Graded on the modified Davis scale — 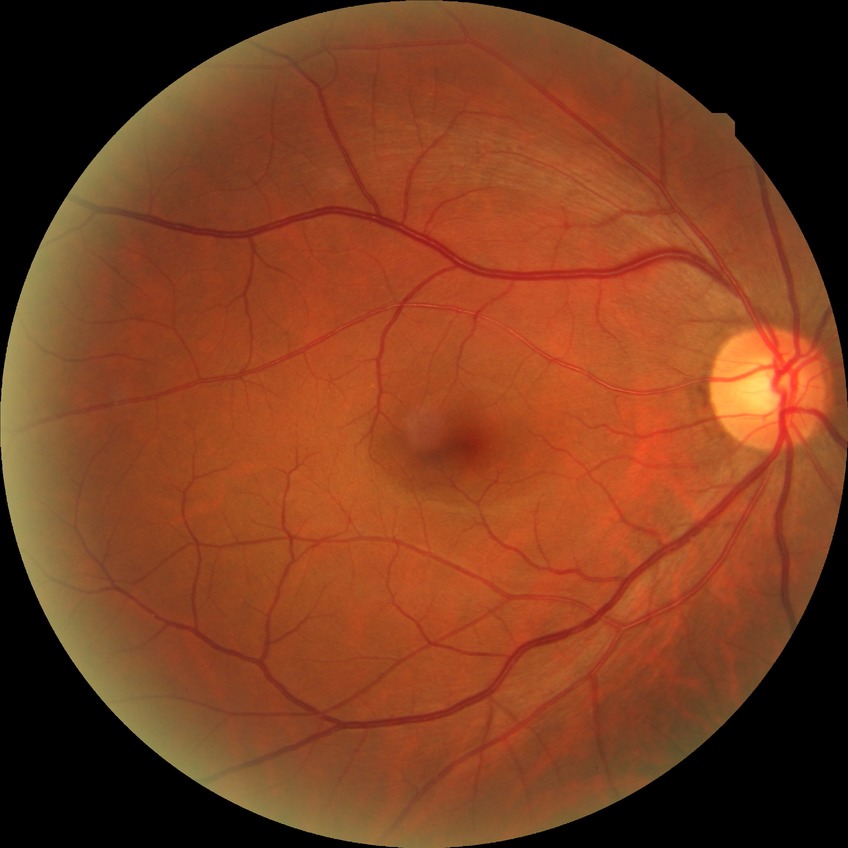

Diabetic retinopathy (DR) is no diabetic retinopathy (NDR).